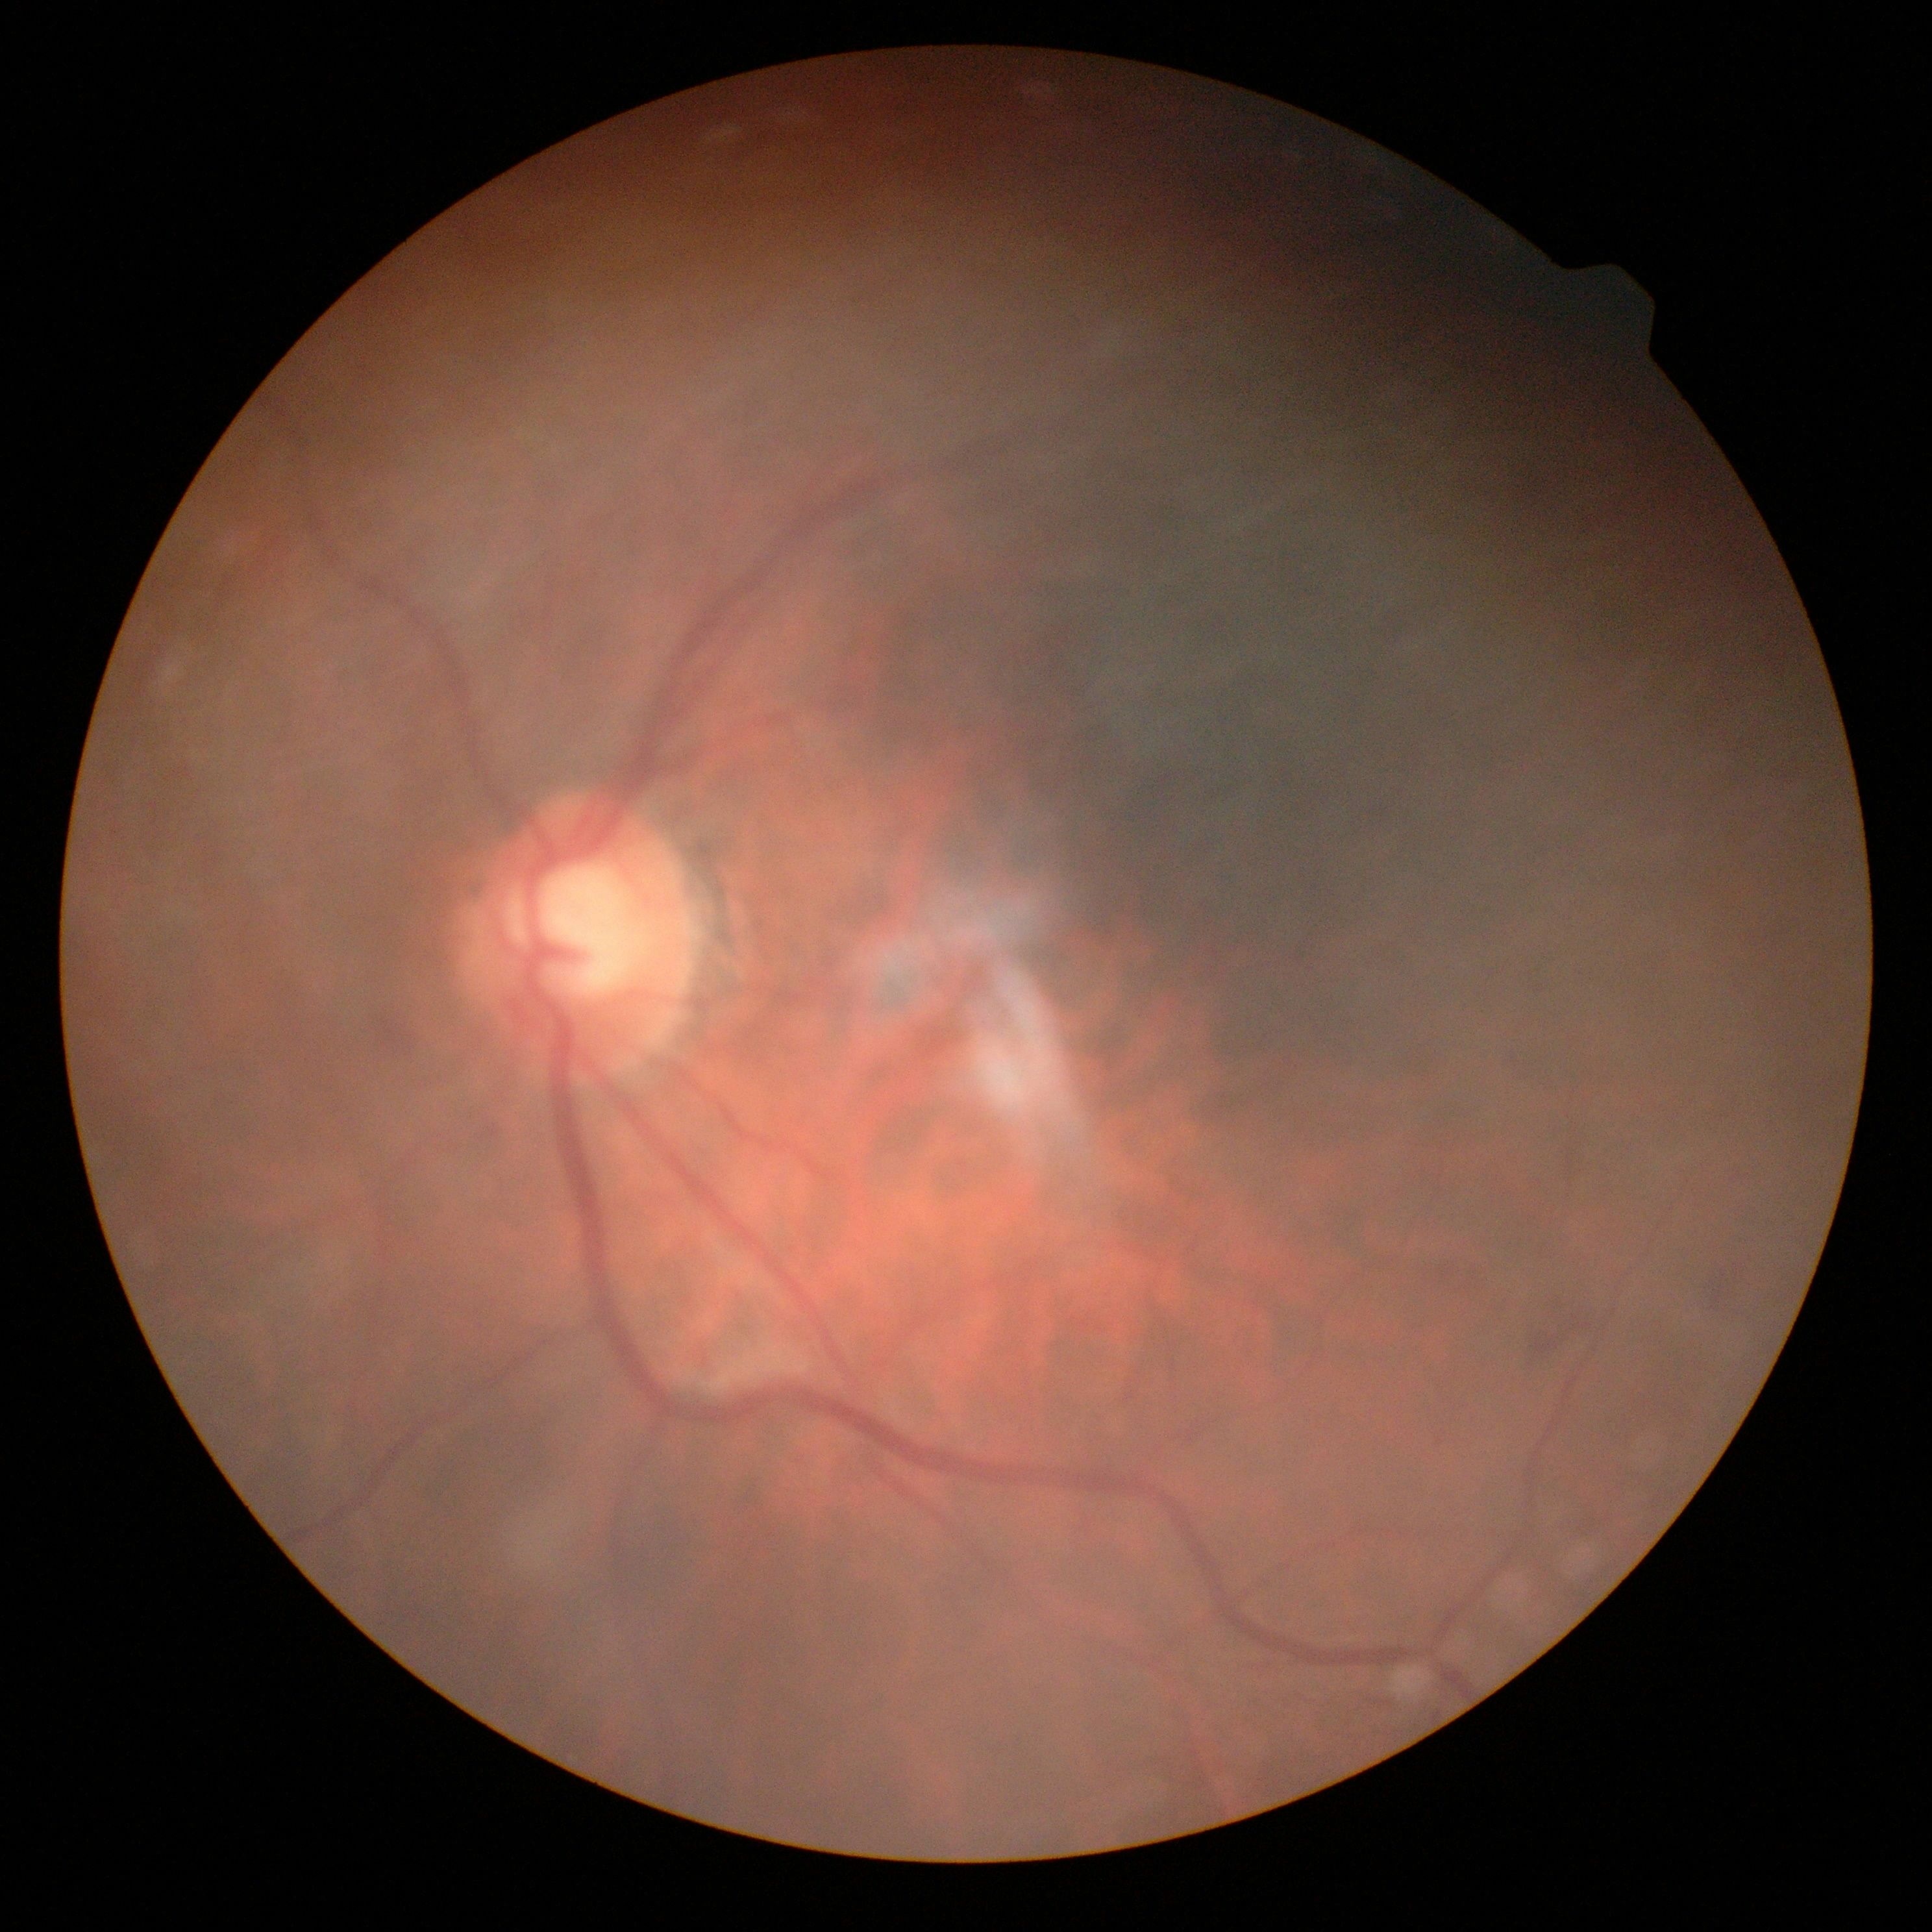
DR class: non-proliferative diabetic retinopathy, DR: 2.